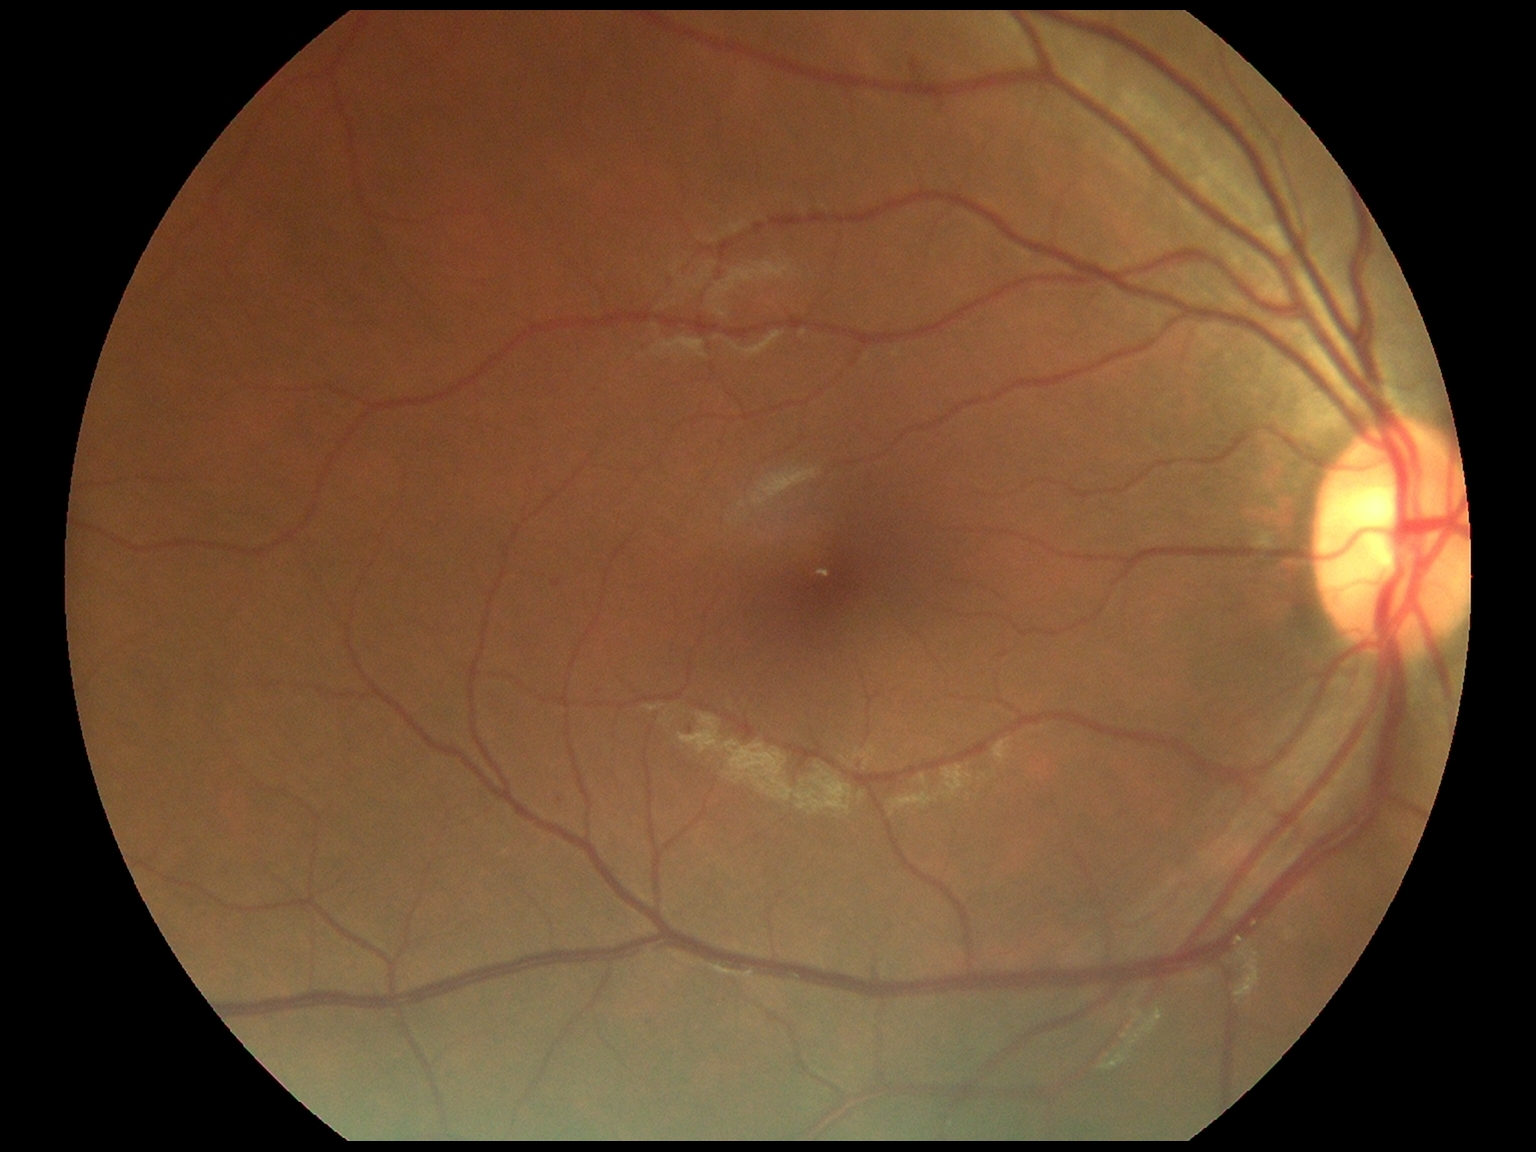
Diabetic retinopathy (DR): grade 1 (mild NPDR).